FOV: 50 degrees:
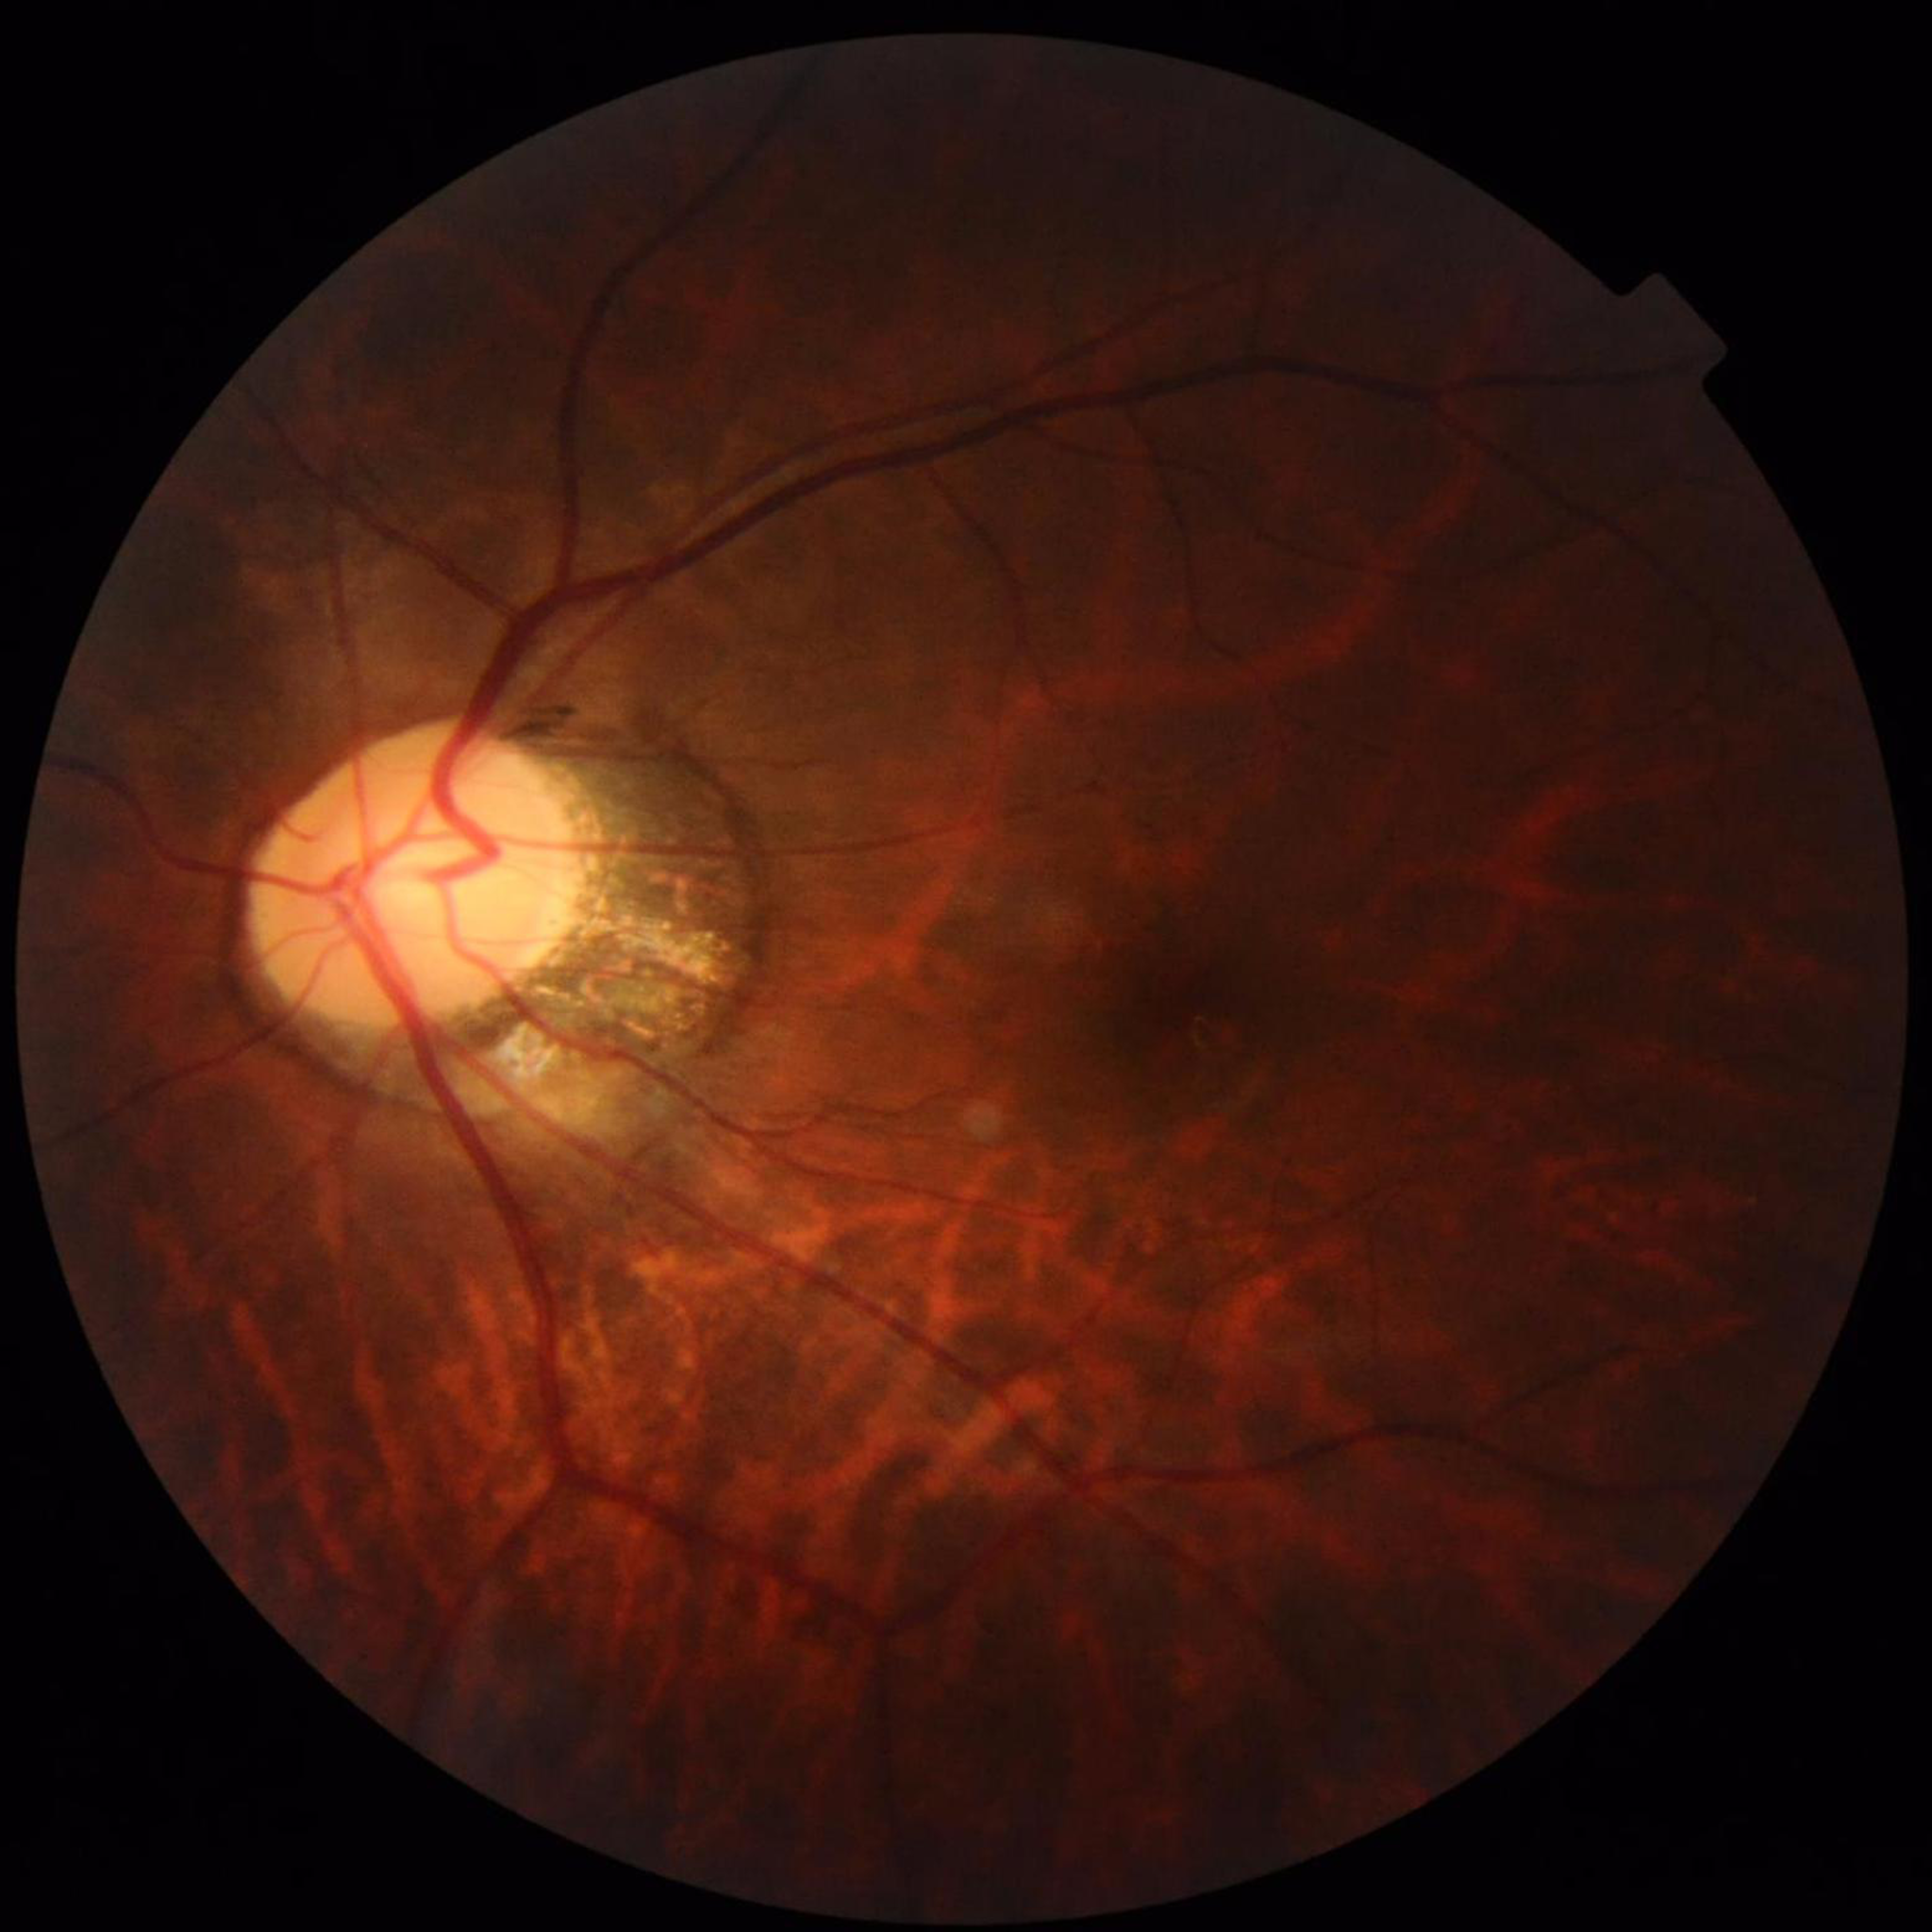 Fundus image of an eye with glaucoma.